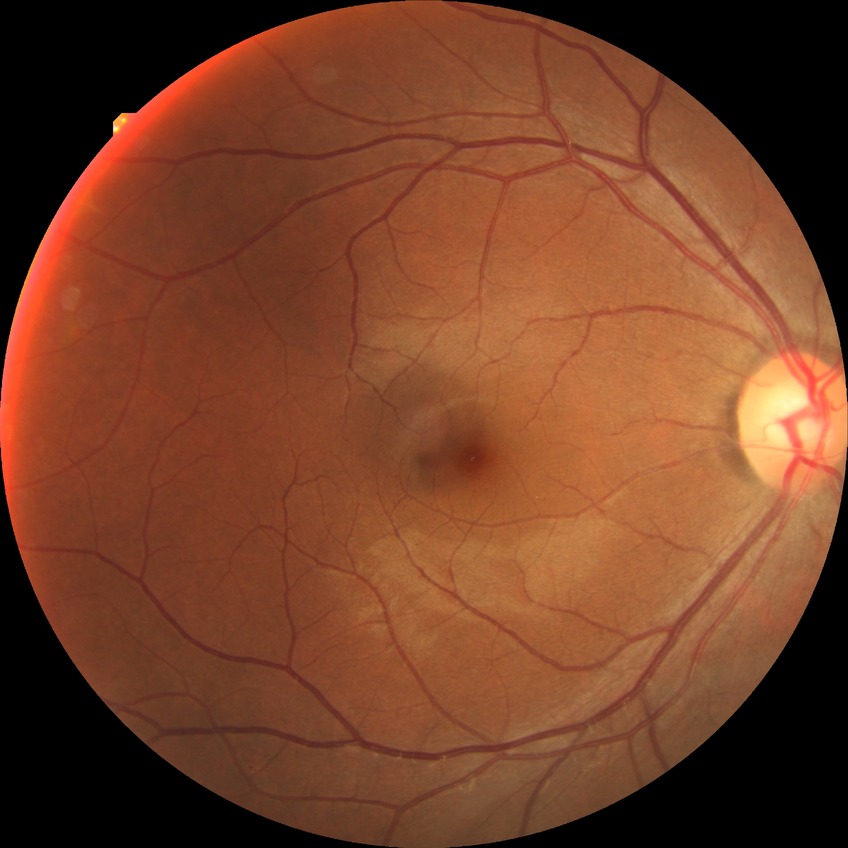

{"davis_grade": "NDR (no diabetic retinopathy)"}